UWF retinal mosaic; 200° field of view
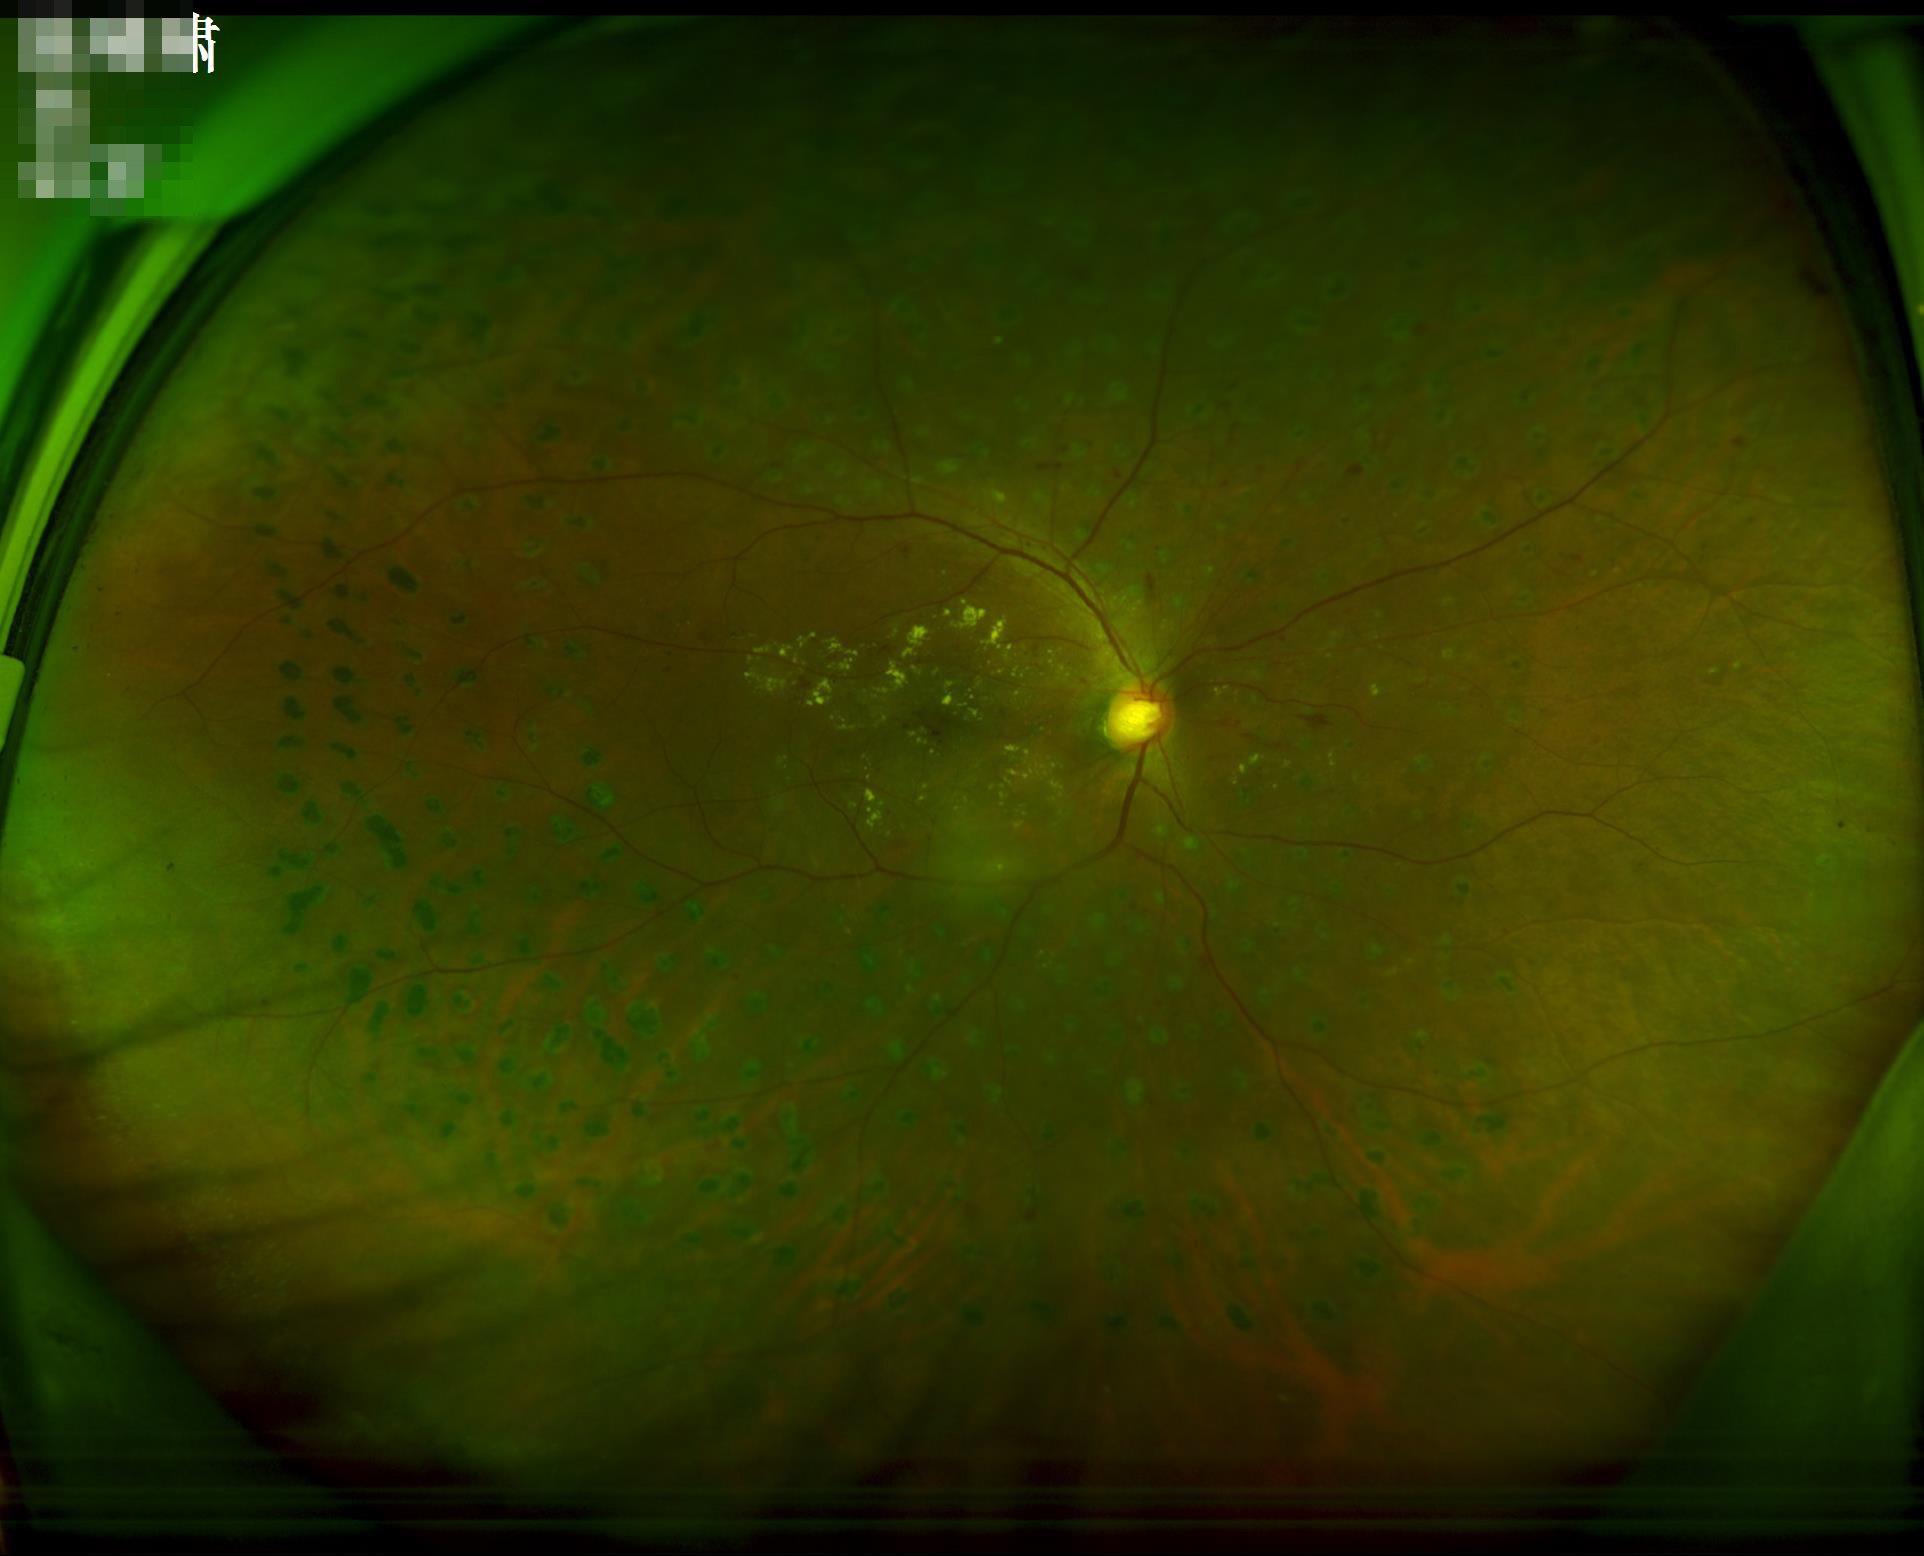 Overall image quality = adequate for clinical interpretation | Focus = optic disc, vessels, and background in focus | Contrast = wide intensity range, structures distinguishable | Illumination/color = even and well-balanced.